1932x1932px.
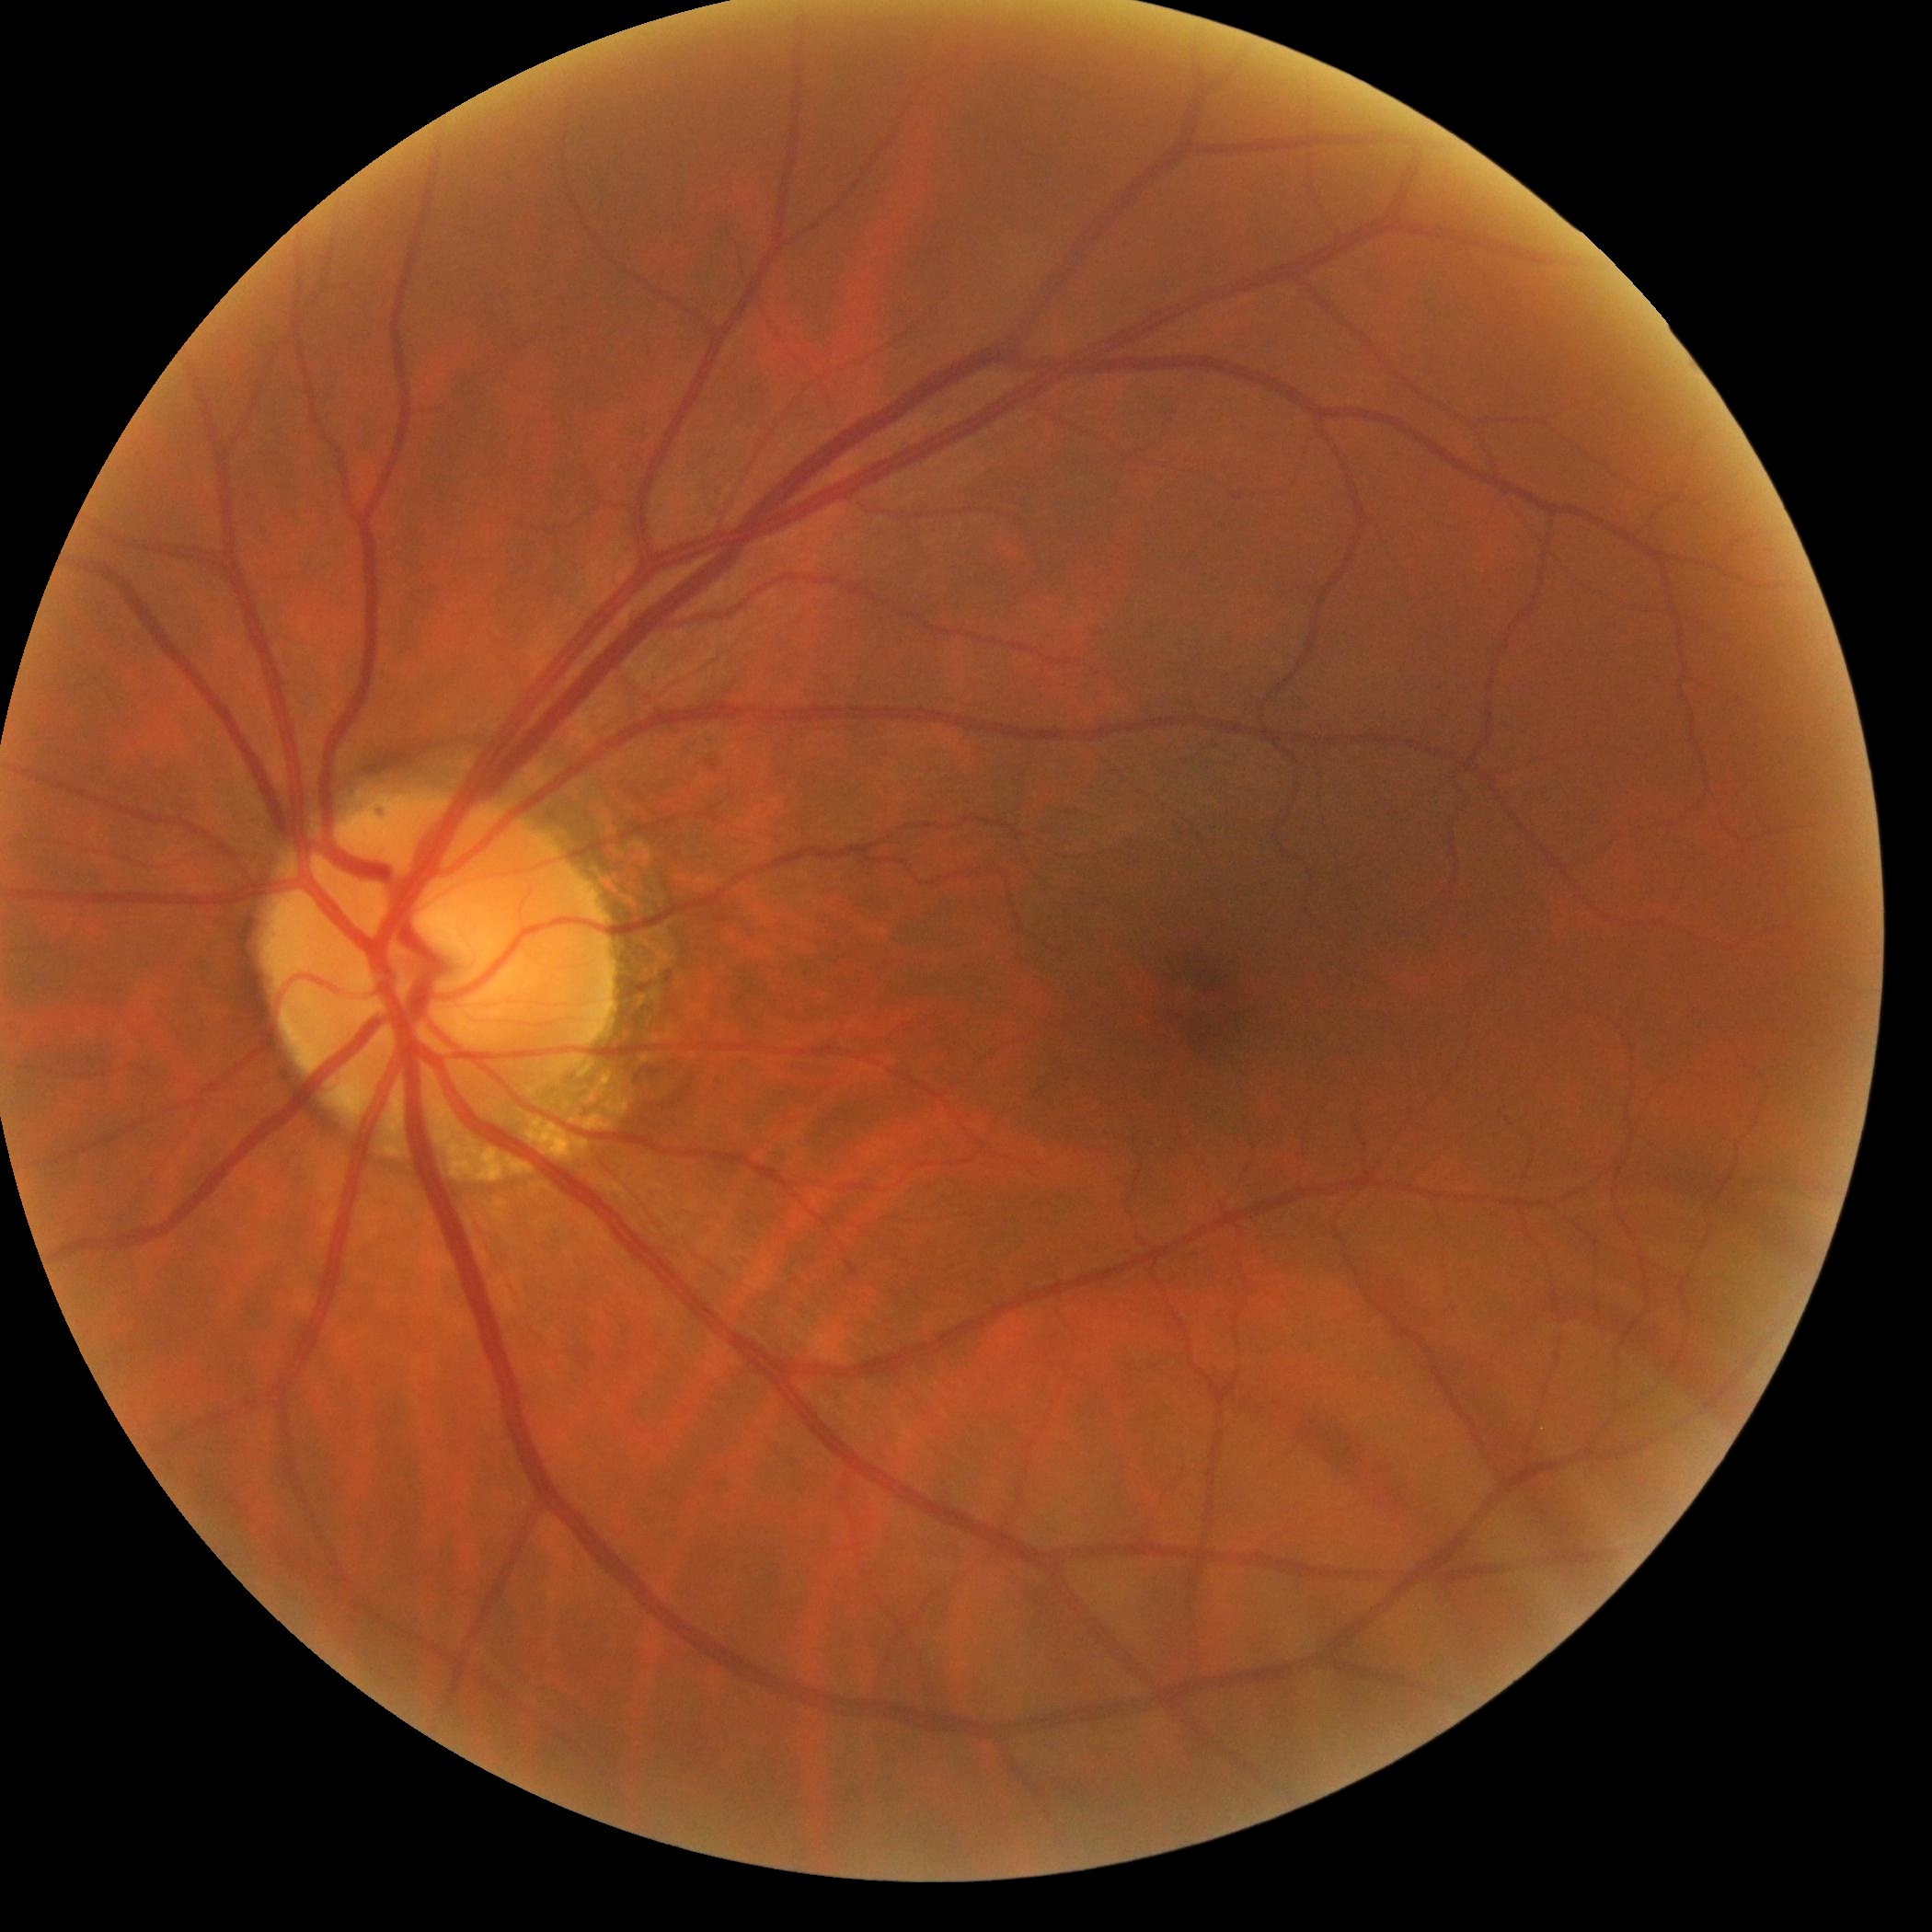

Diabetic retinopathy severity: no apparent diabetic retinopathy (grade 0).